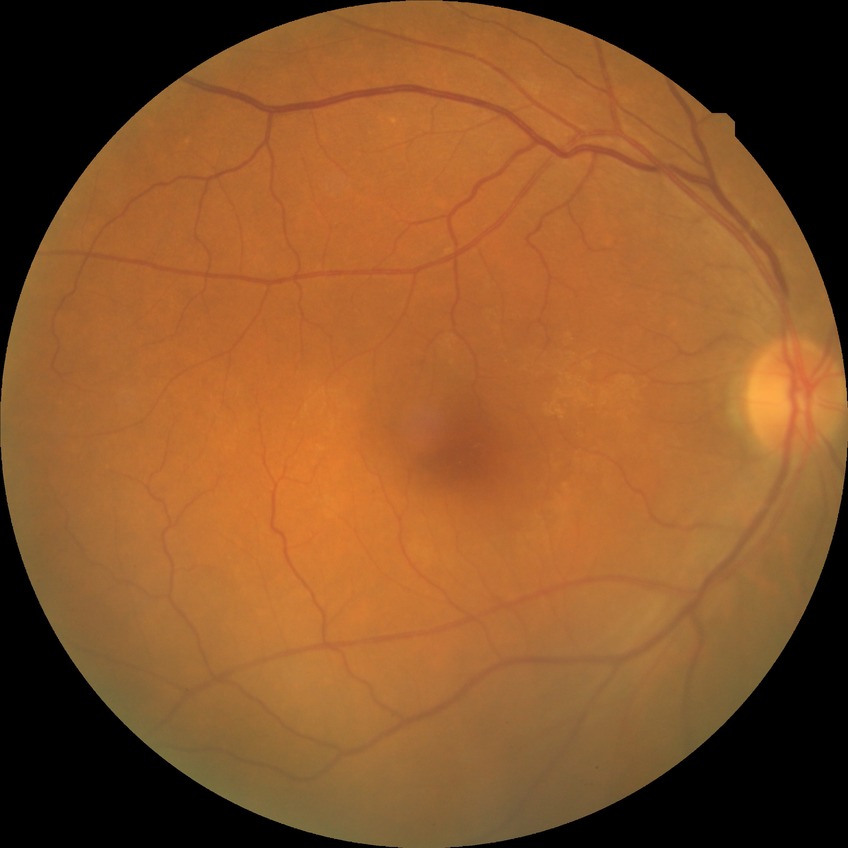
* diabetic retinopathy (DR) — no diabetic retinopathy (NDR)